Camera: NIDEK AFC-230 · 45-degree field of view · fundus photo — 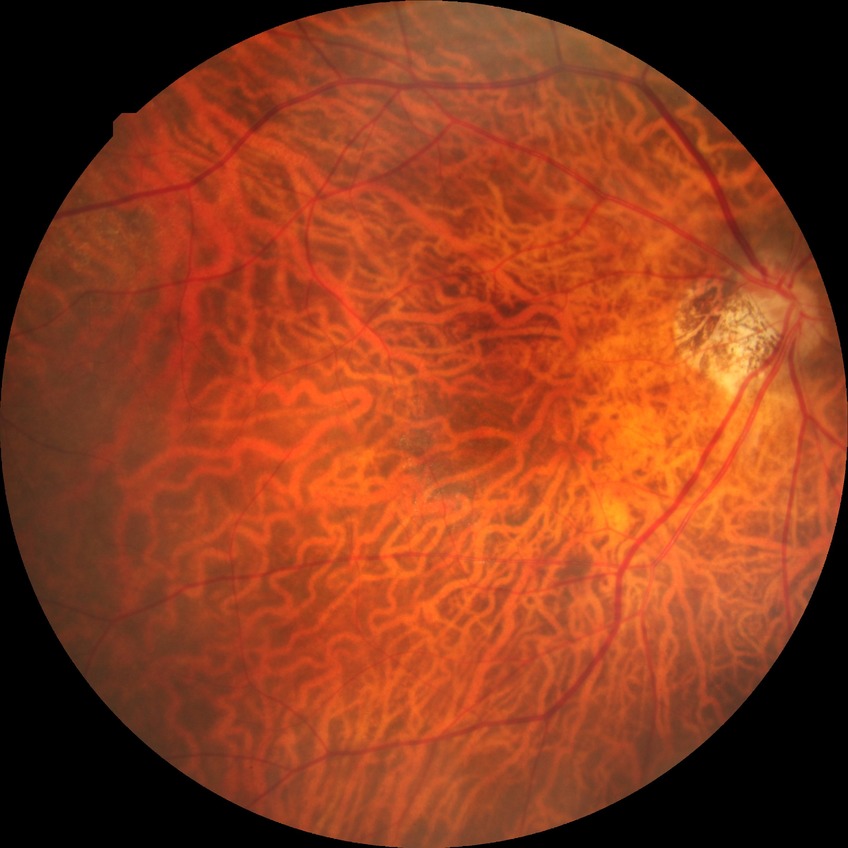

No signs of diabetic retinopathy.
DR stage: NDR.